NIDEK AFC-230 fundus camera. Davis DR grading.
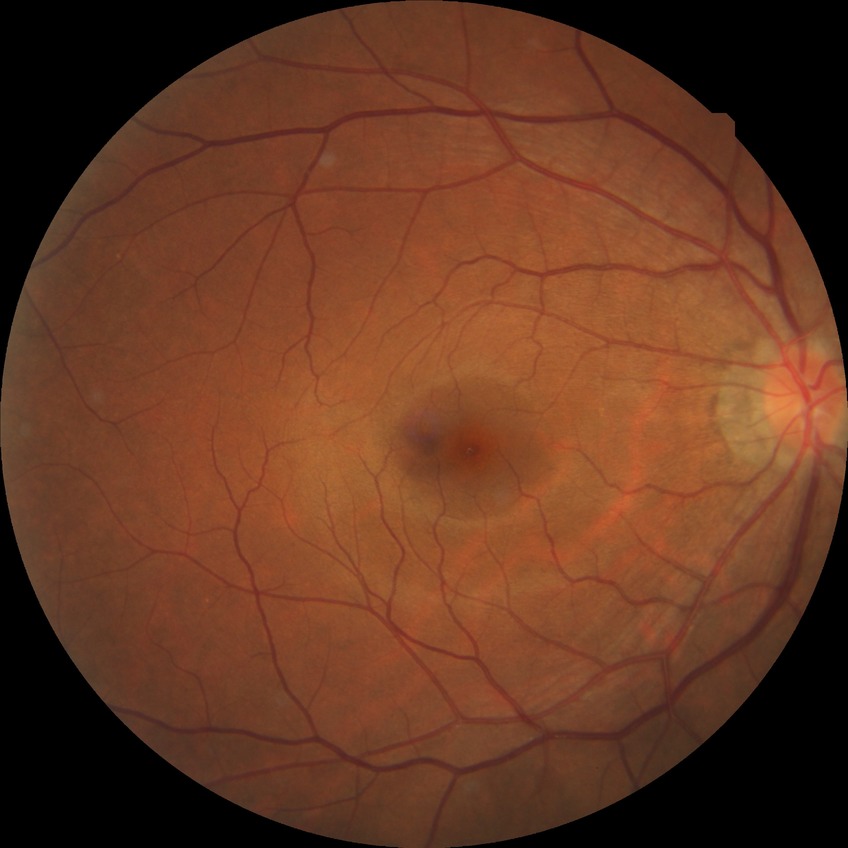
{
  "davis_grade": "no diabetic retinopathy"
}